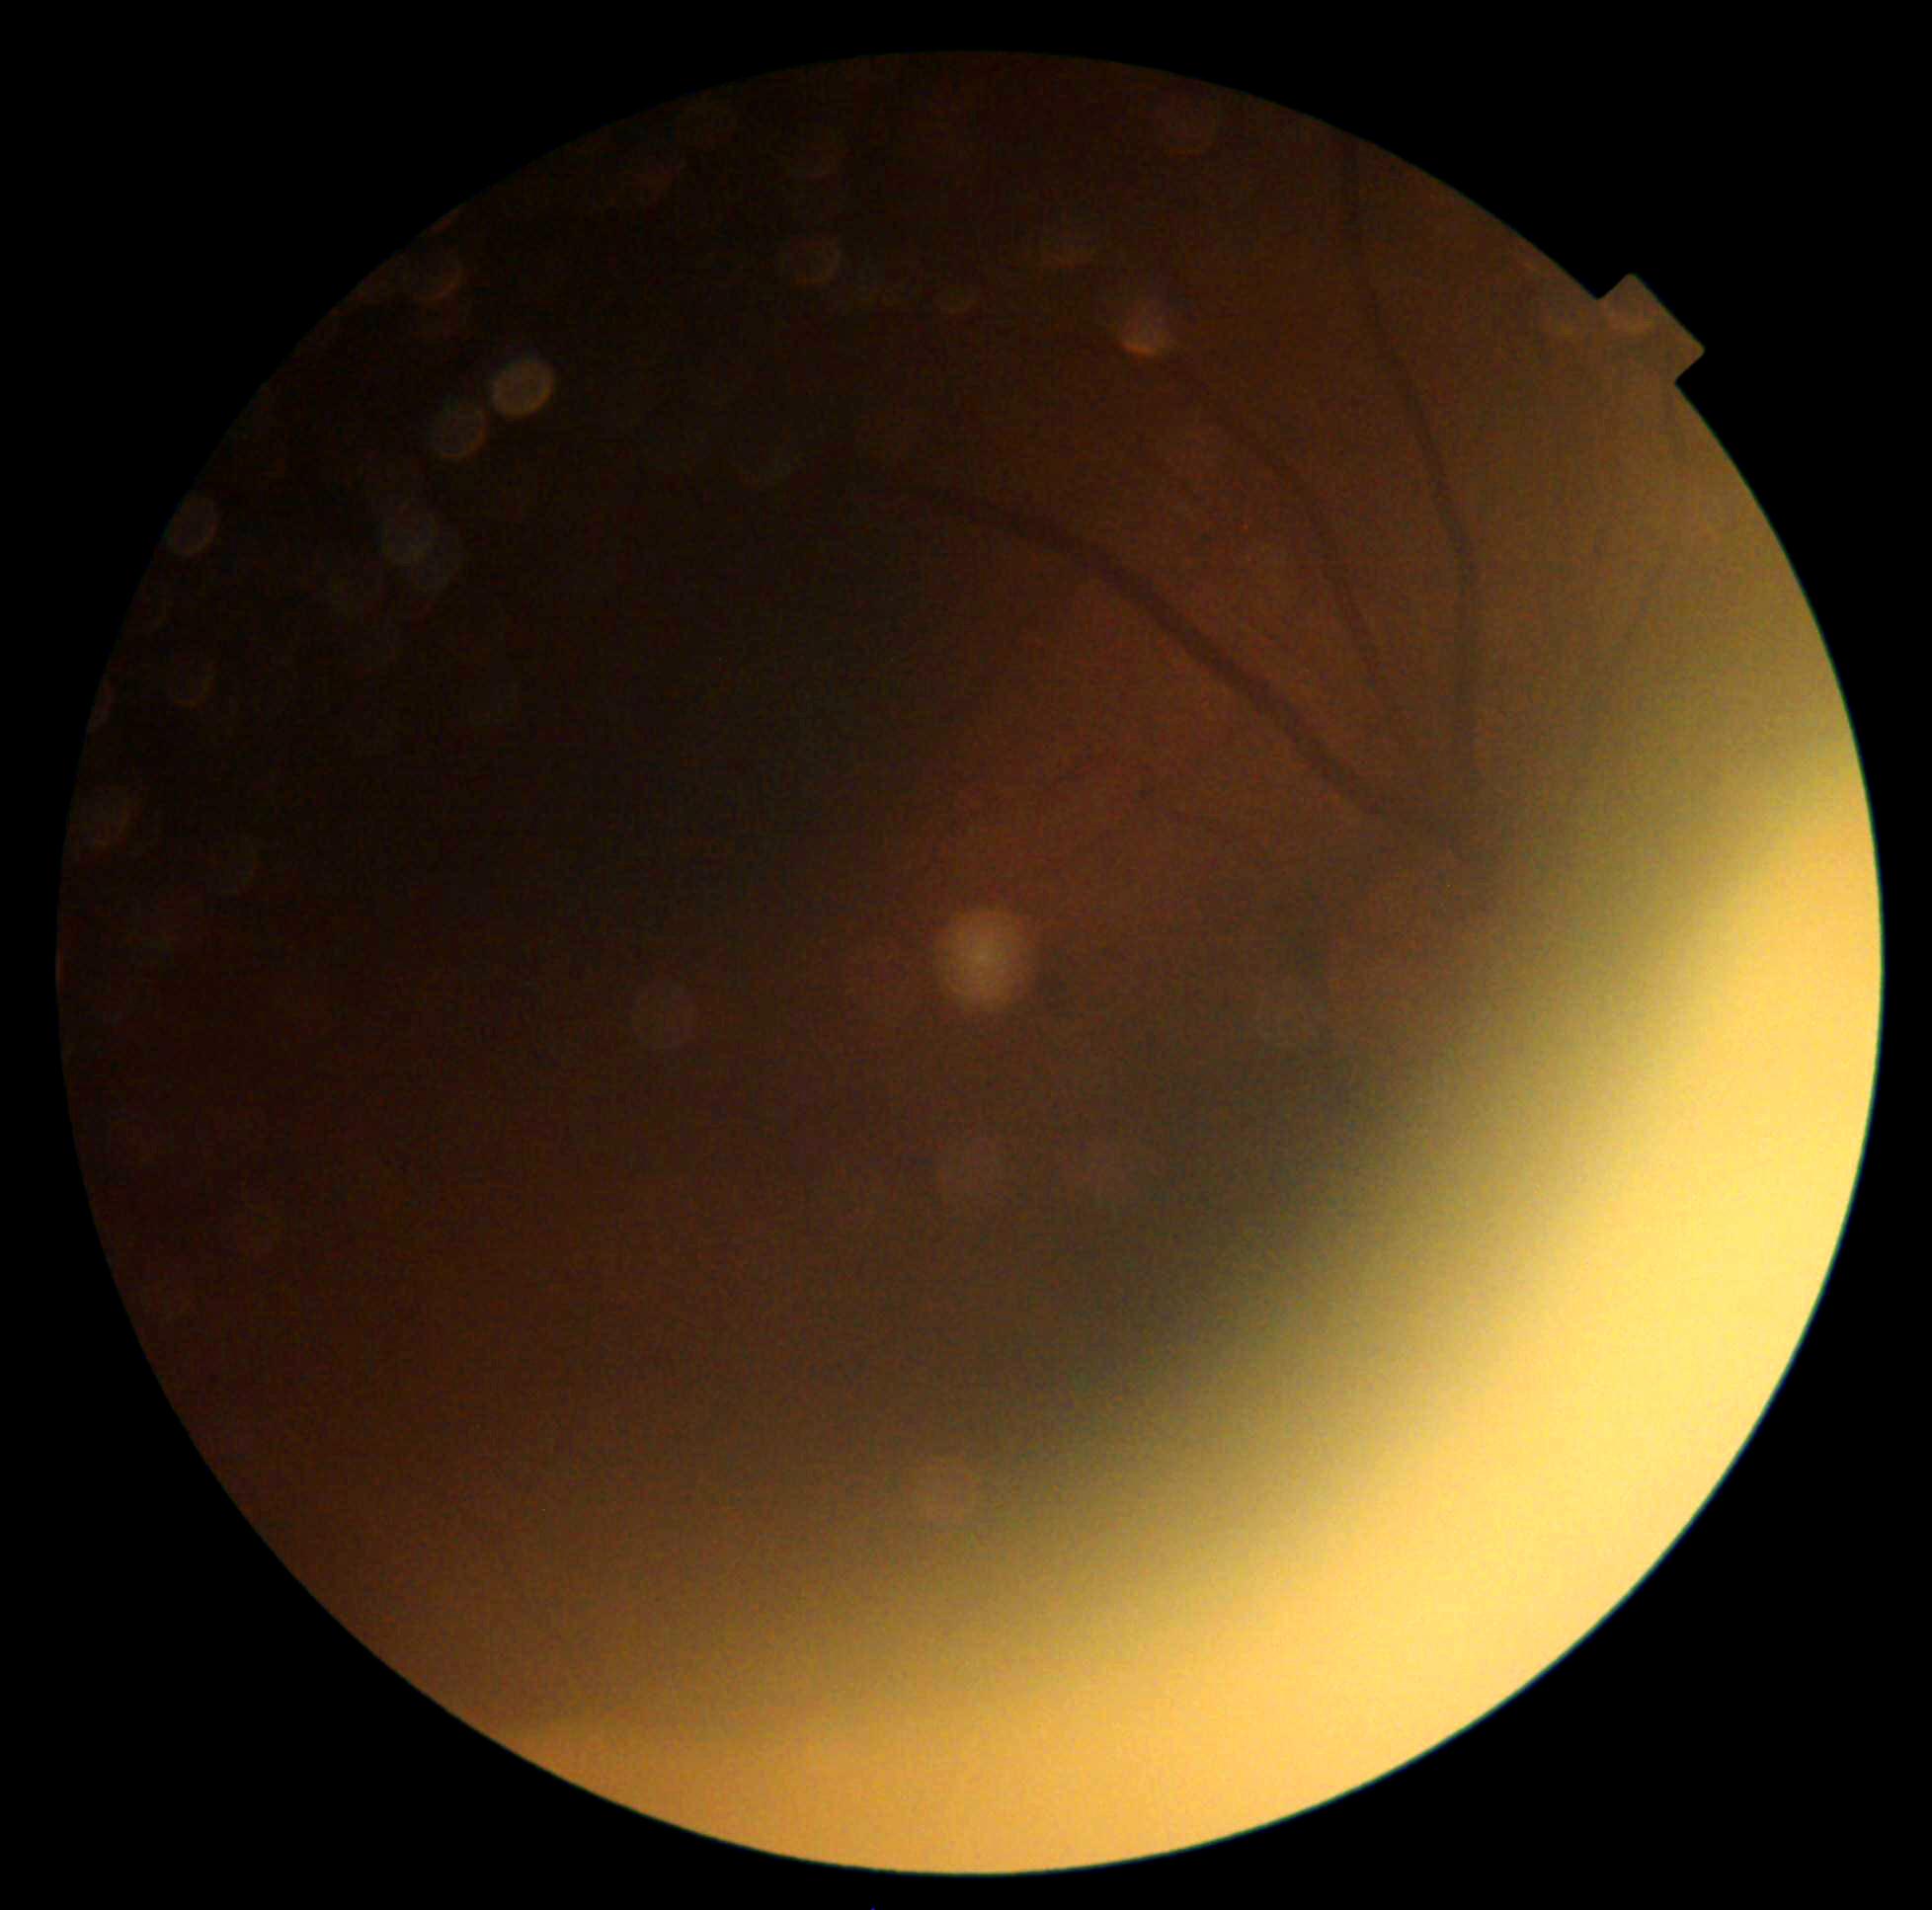

DR severity is ungradable due to poor image quality.